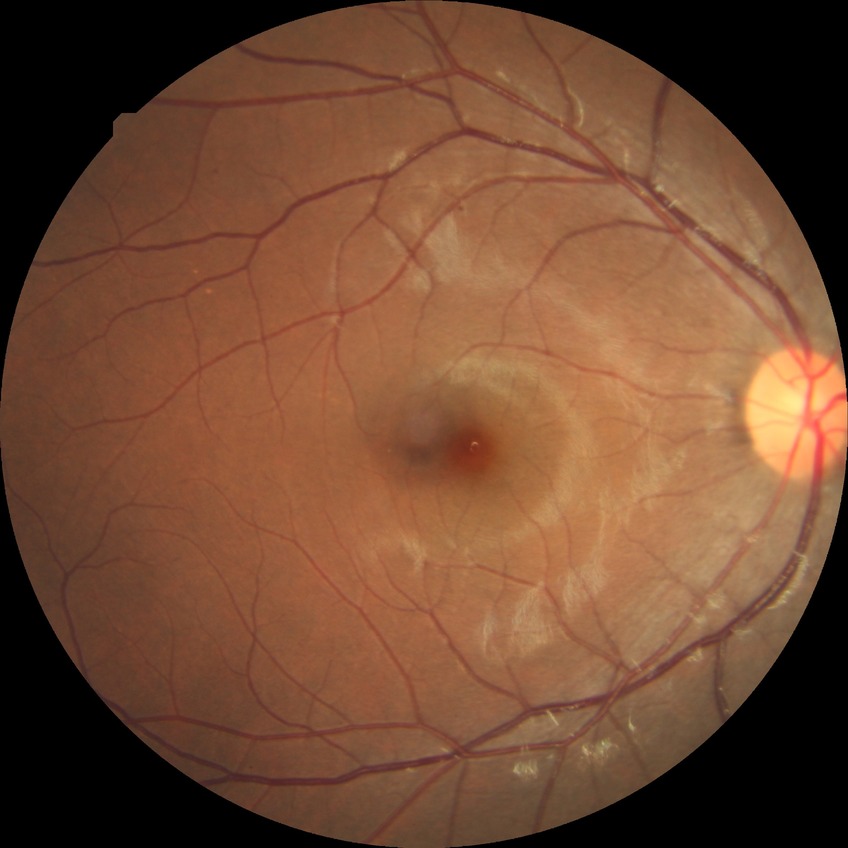
Diabetic retinopathy grade is simple diabetic retinopathy.